Infant wide-field retinal image · captured with the Phoenix ICON (100° field of view).
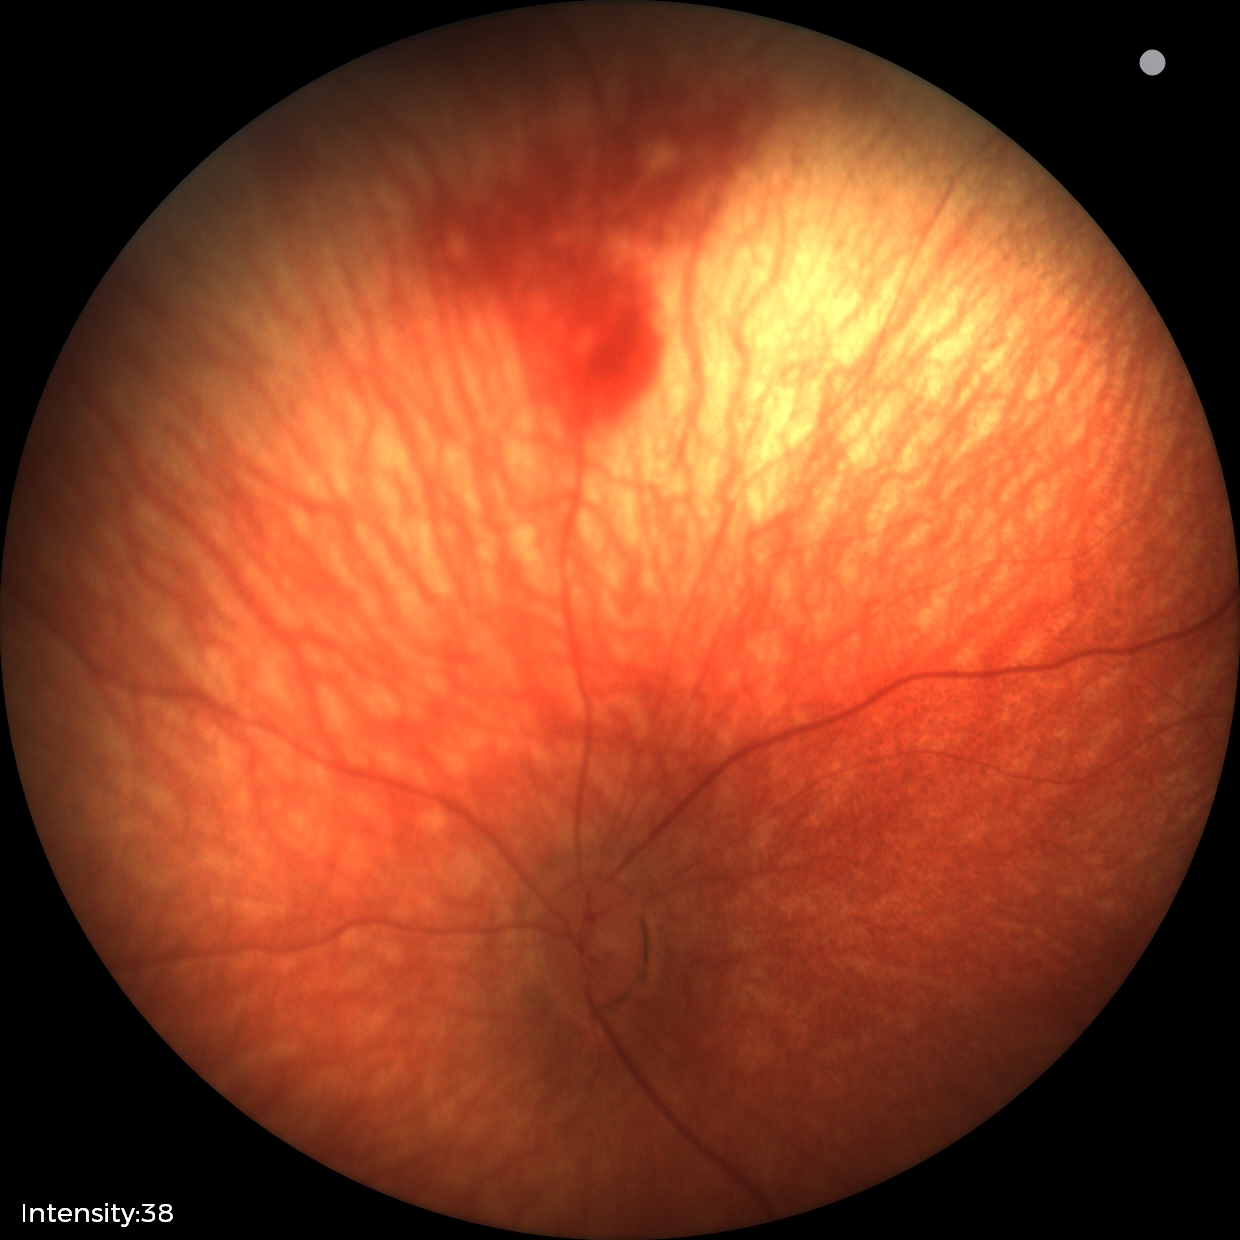
Diagnosis: retinal hemorrhages.